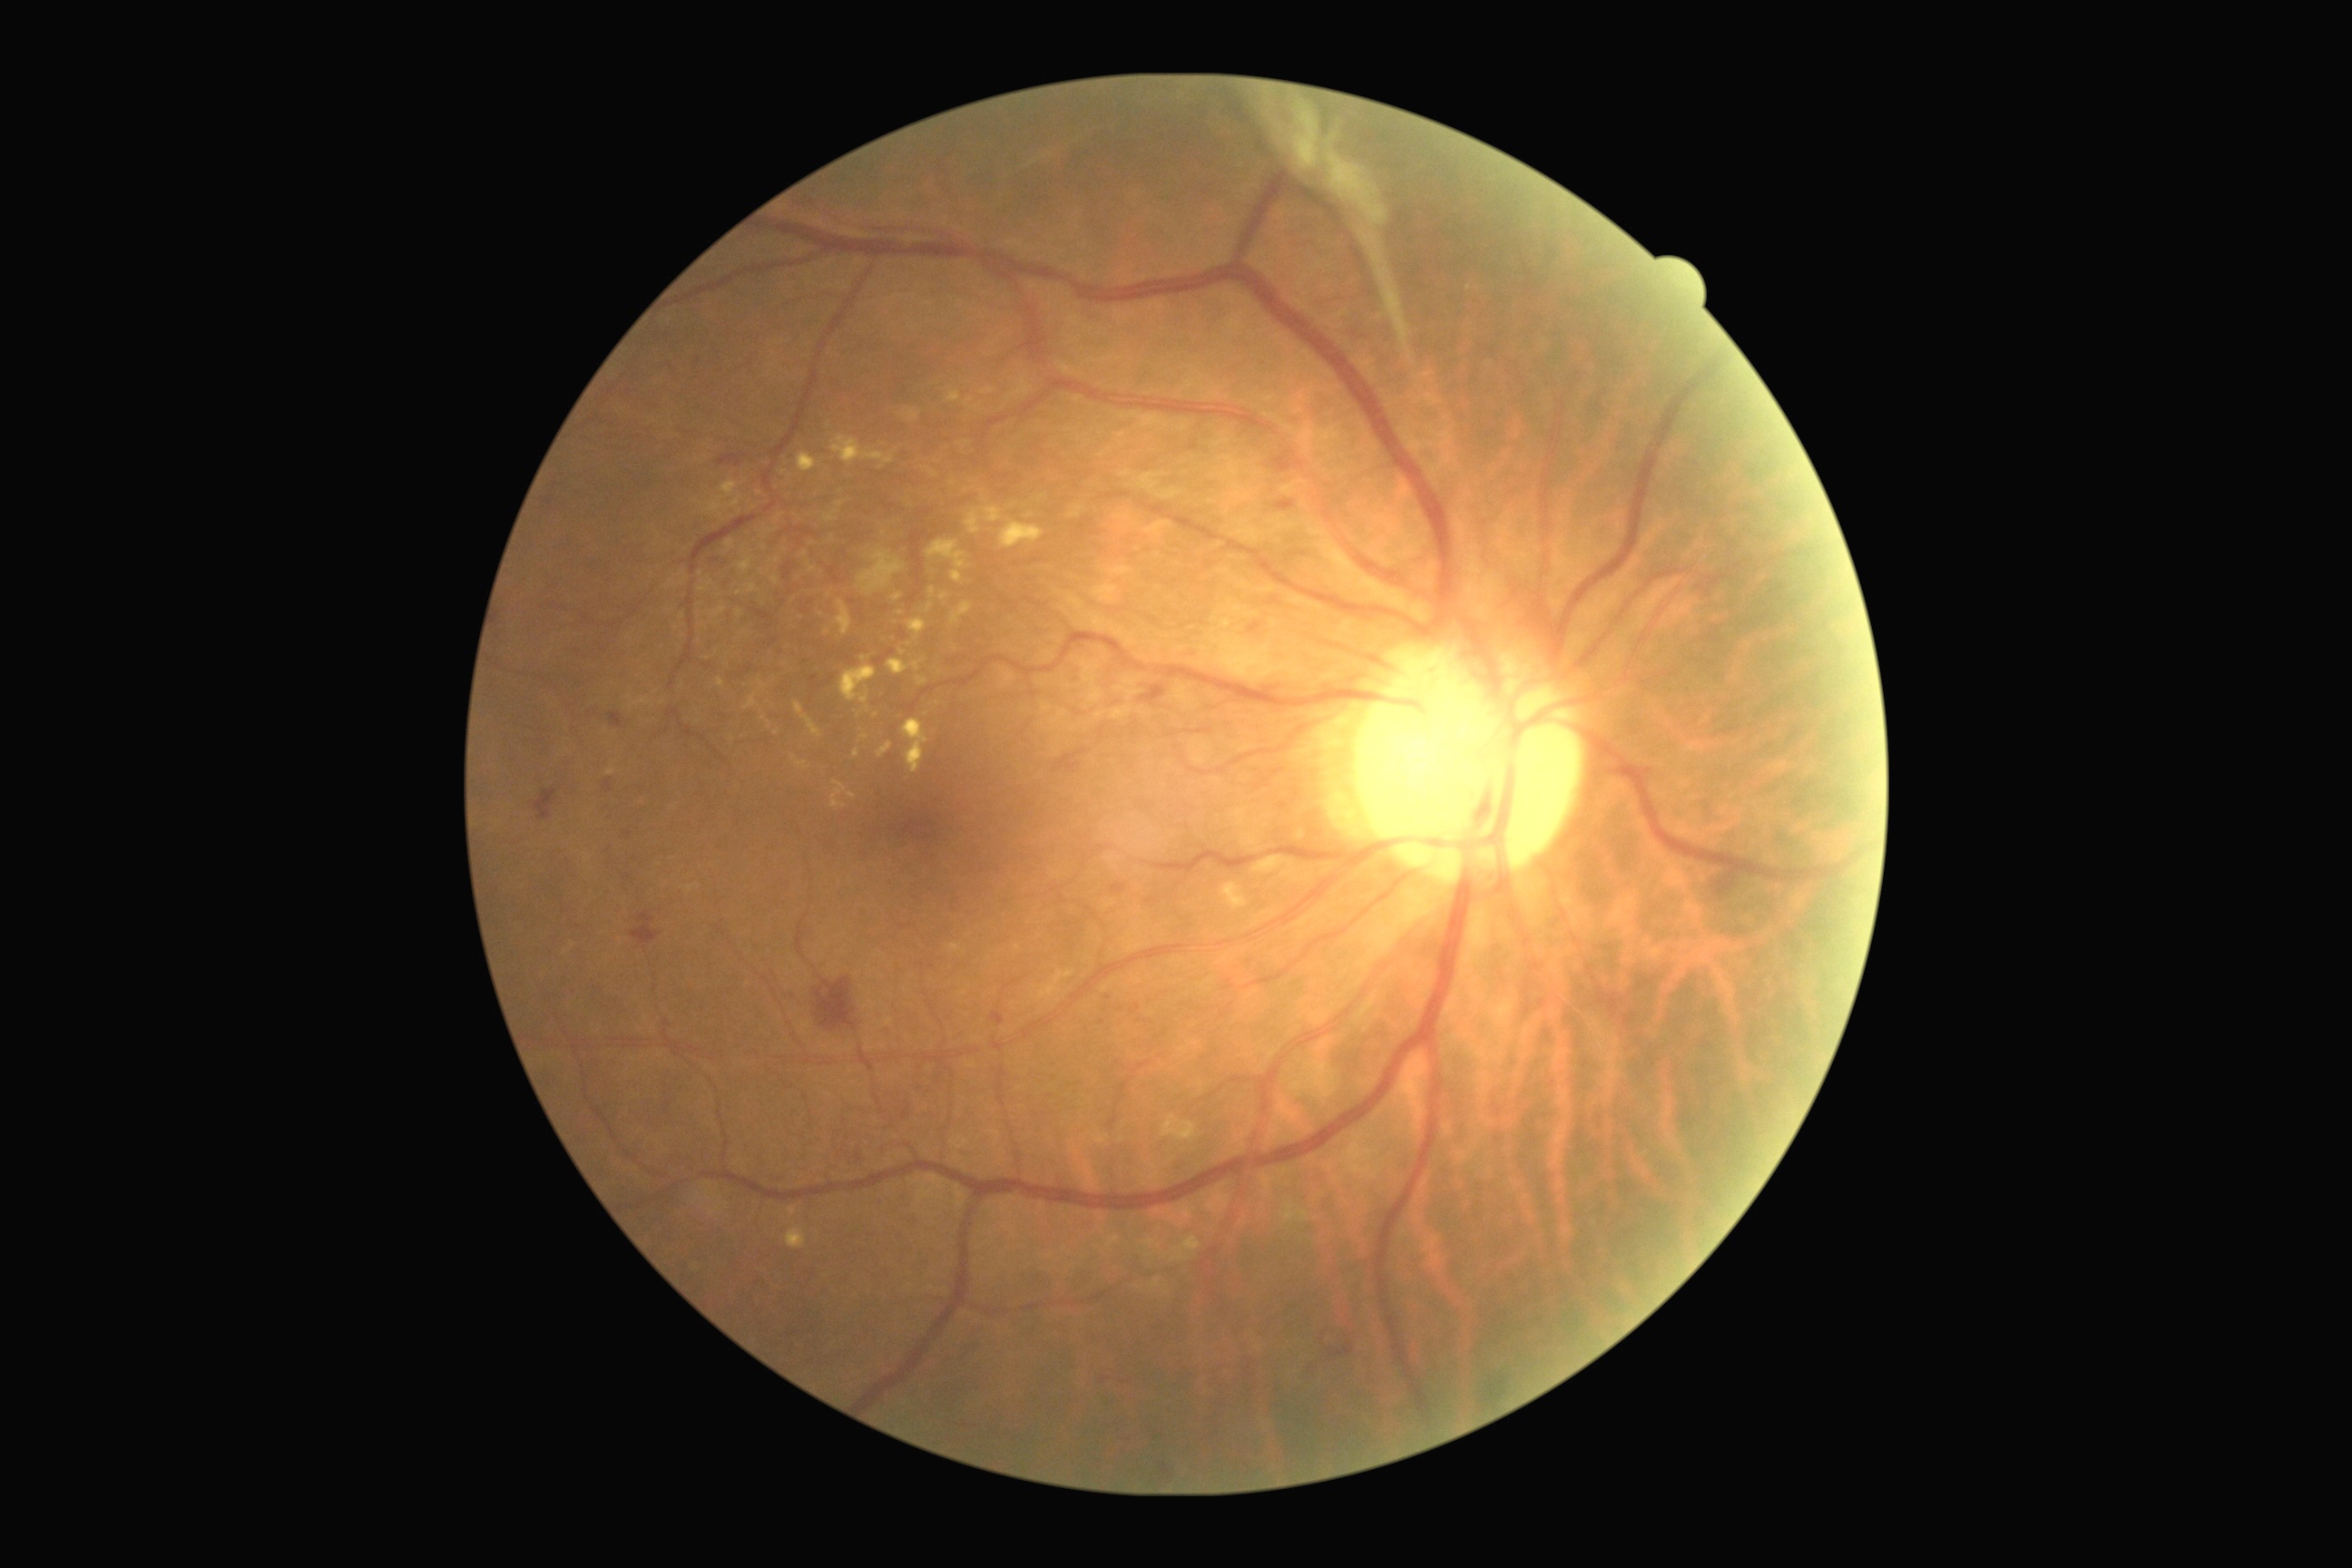

<lesions partial="true">
  <dr_grade>4</dr_grade>
  <he partial="true">BBox(816, 979, 858, 1030) | BBox(631, 914, 660, 945) | BBox(1716, 868, 1740, 897) | BBox(1328, 1333, 1355, 1358) | BBox(1306, 1362, 1320, 1378) | BBox(1275, 500, 1295, 513) | BBox(785, 564, 792, 580) | BBox(534, 789, 558, 819) | BBox(1141, 687, 1166, 701) | BBox(609, 712, 625, 729) | BBox(1093, 1375, 1108, 1387) | BBox(1161, 1465, 1171, 1482) | BBox(1122, 1438, 1135, 1446) | BBox(718, 455, 741, 467) | BBox(1707, 574, 1727, 585) | BBox(1213, 1404, 1222, 1426) | BBox(1112, 885, 1126, 894) | BBox(1273, 455, 1293, 473) | BBox(605, 778, 612, 794)</he>
  <se />
  <ma partial="true">BBox(623, 832, 631, 836) | BBox(810, 676, 818, 681) | BBox(858, 1153, 861, 1161) | BBox(992, 1012, 1004, 1026) | BBox(903, 1106, 912, 1119)</ma>
  <ma_small_approx>point(1102, 1022)</ma_small_approx>
  <ex partial="true">BBox(888, 660, 923, 676) | BBox(798, 453, 818, 473) | BBox(928, 469, 937, 476) | BBox(1106, 1237, 1121, 1248) | BBox(828, 534, 834, 544) | BBox(859, 734, 868, 741) | BBox(798, 761, 810, 770) | BBox(832, 435, 899, 471) | BBox(1222, 883, 1250, 912) | BBox(758, 680, 767, 691) | BBox(823, 509, 839, 524) | BBox(727, 540, 734, 551) | BBox(903, 720, 928, 774) | BBox(720, 480, 738, 496)</ex>
  <ex_small_approx>point(826, 632) | point(740, 593) | point(770, 724) | point(710, 585) | point(776, 733) | point(885, 534)</ex_small_approx>
</lesions>